Pupil-dilated, acquired with a Topcon TRC-50DX, FOV: 50 degrees, image size 2228x1652, posterior pole view, CFP.
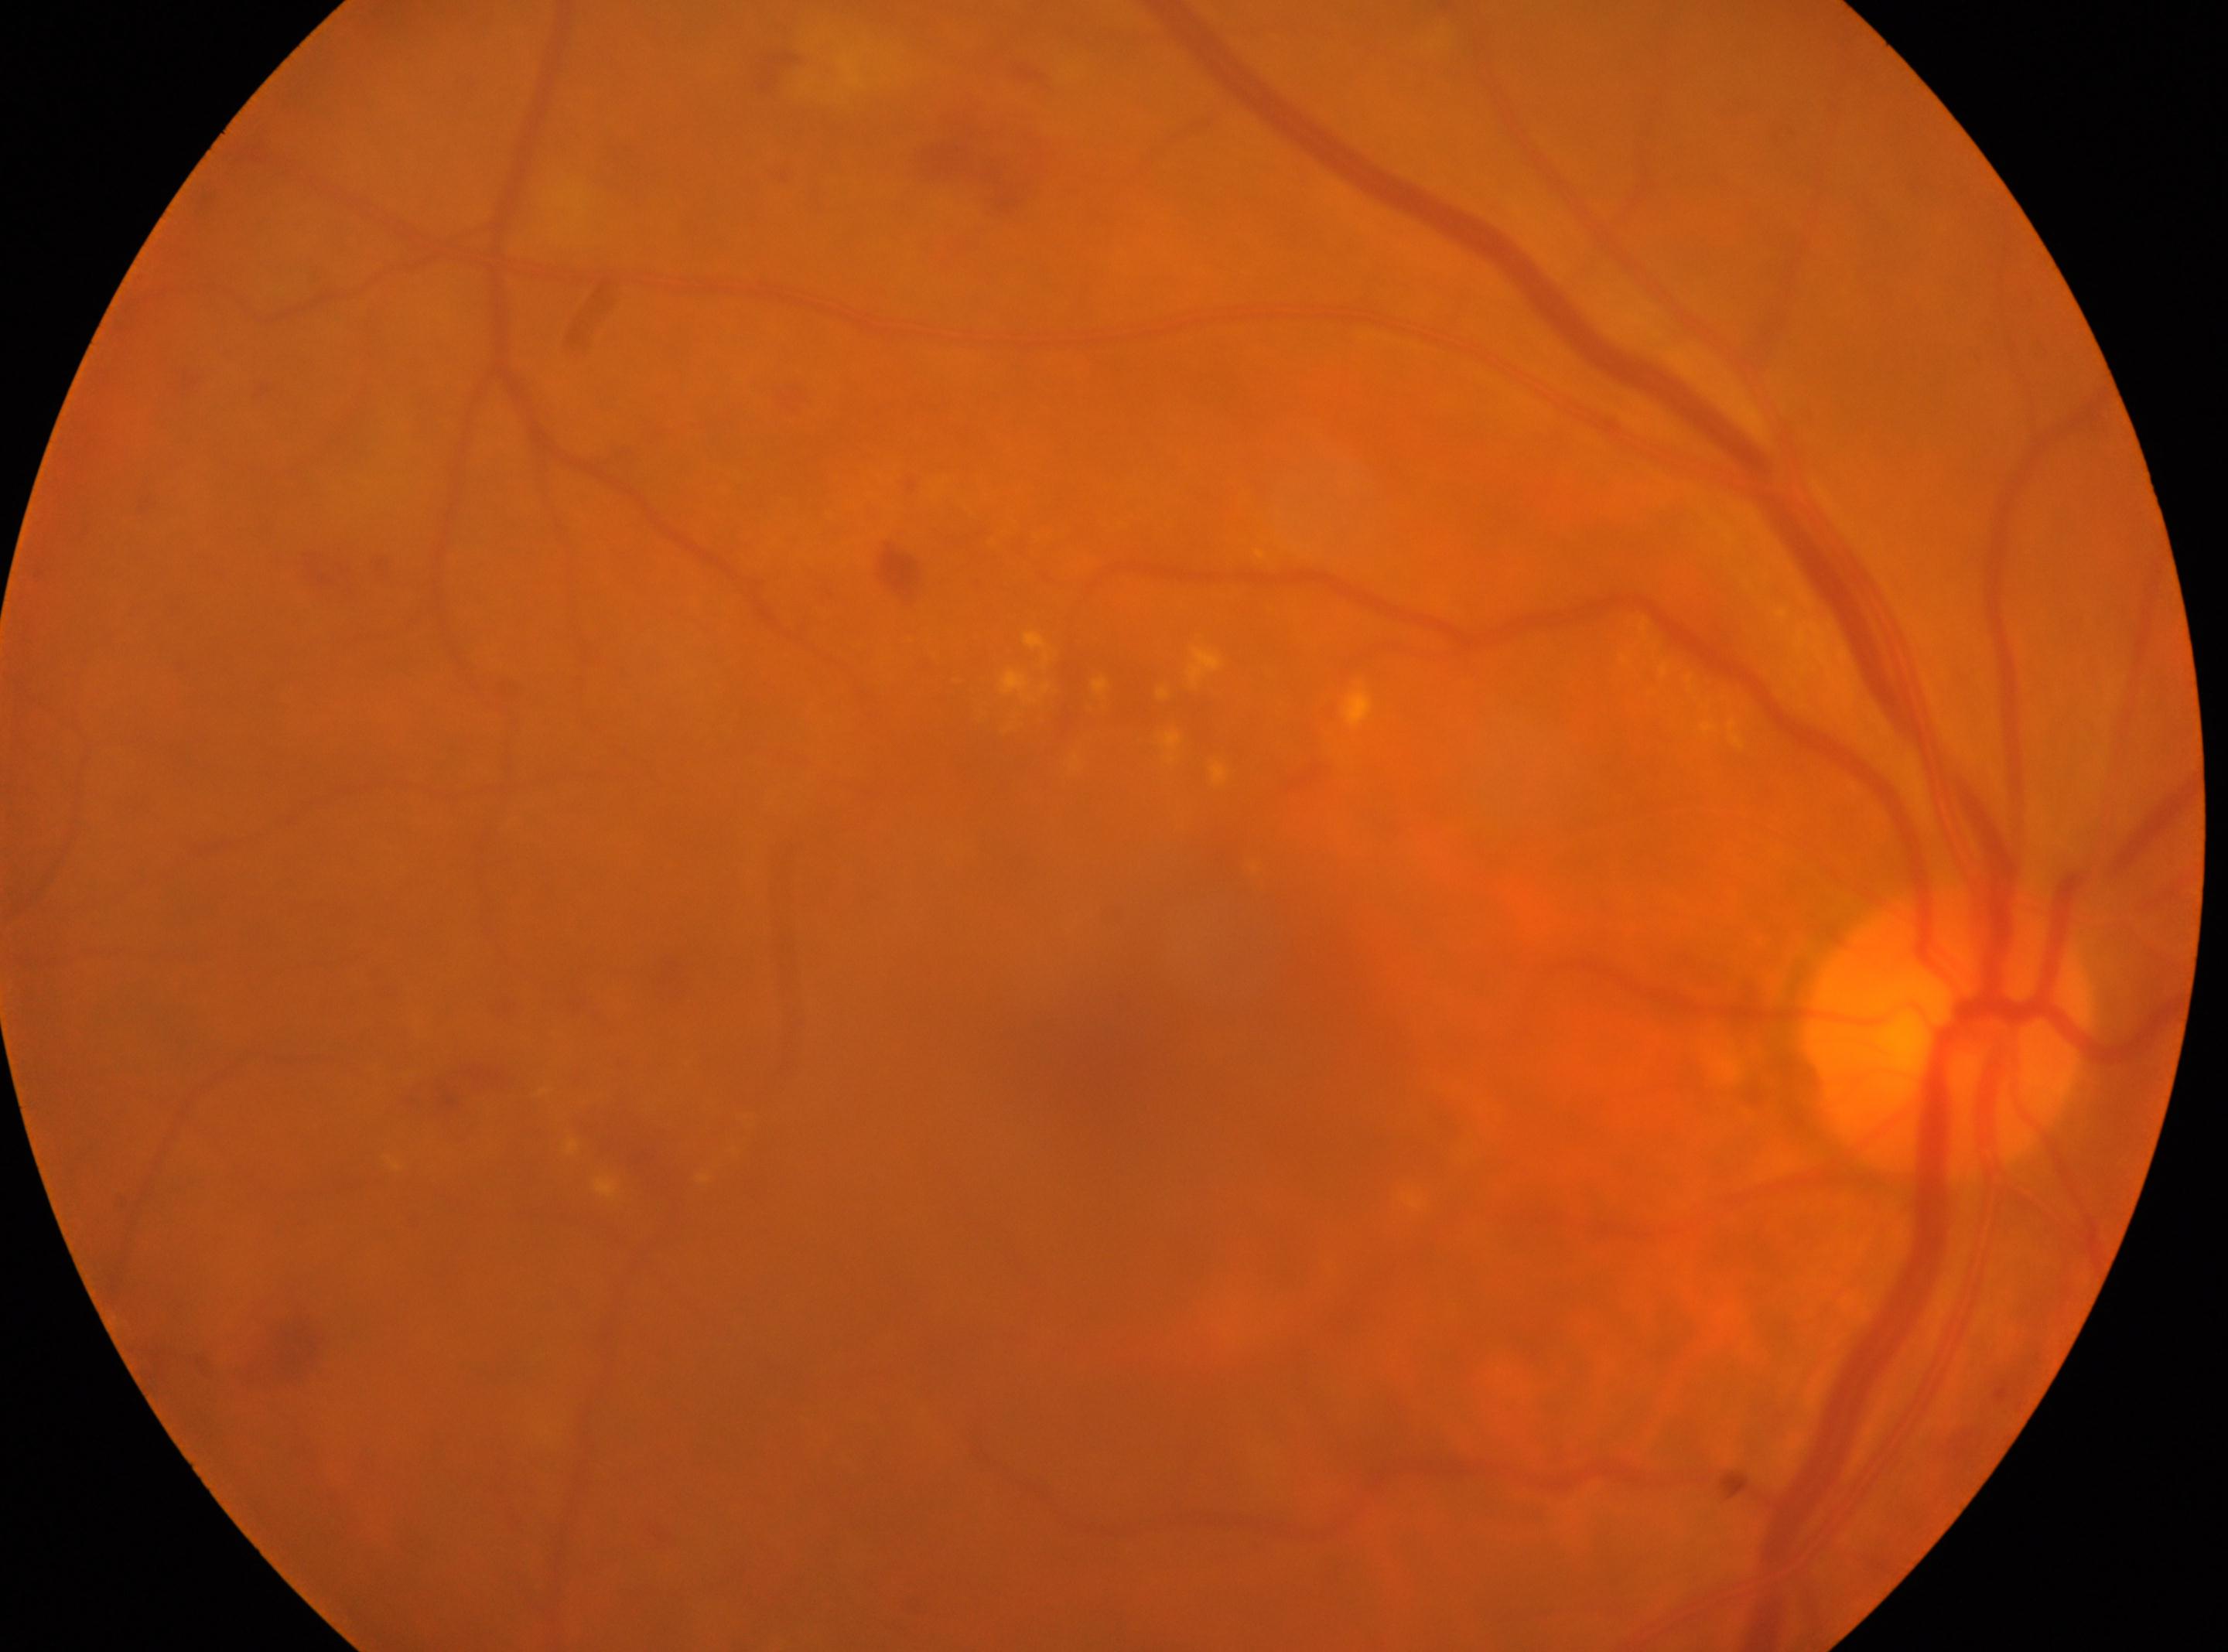
{"eye": "OD", "dr_grade": "2", "optic_disc": "[1946, 1030]", "fovea": "[1117, 1039]"}